Fundus photo; 2048x1536px: 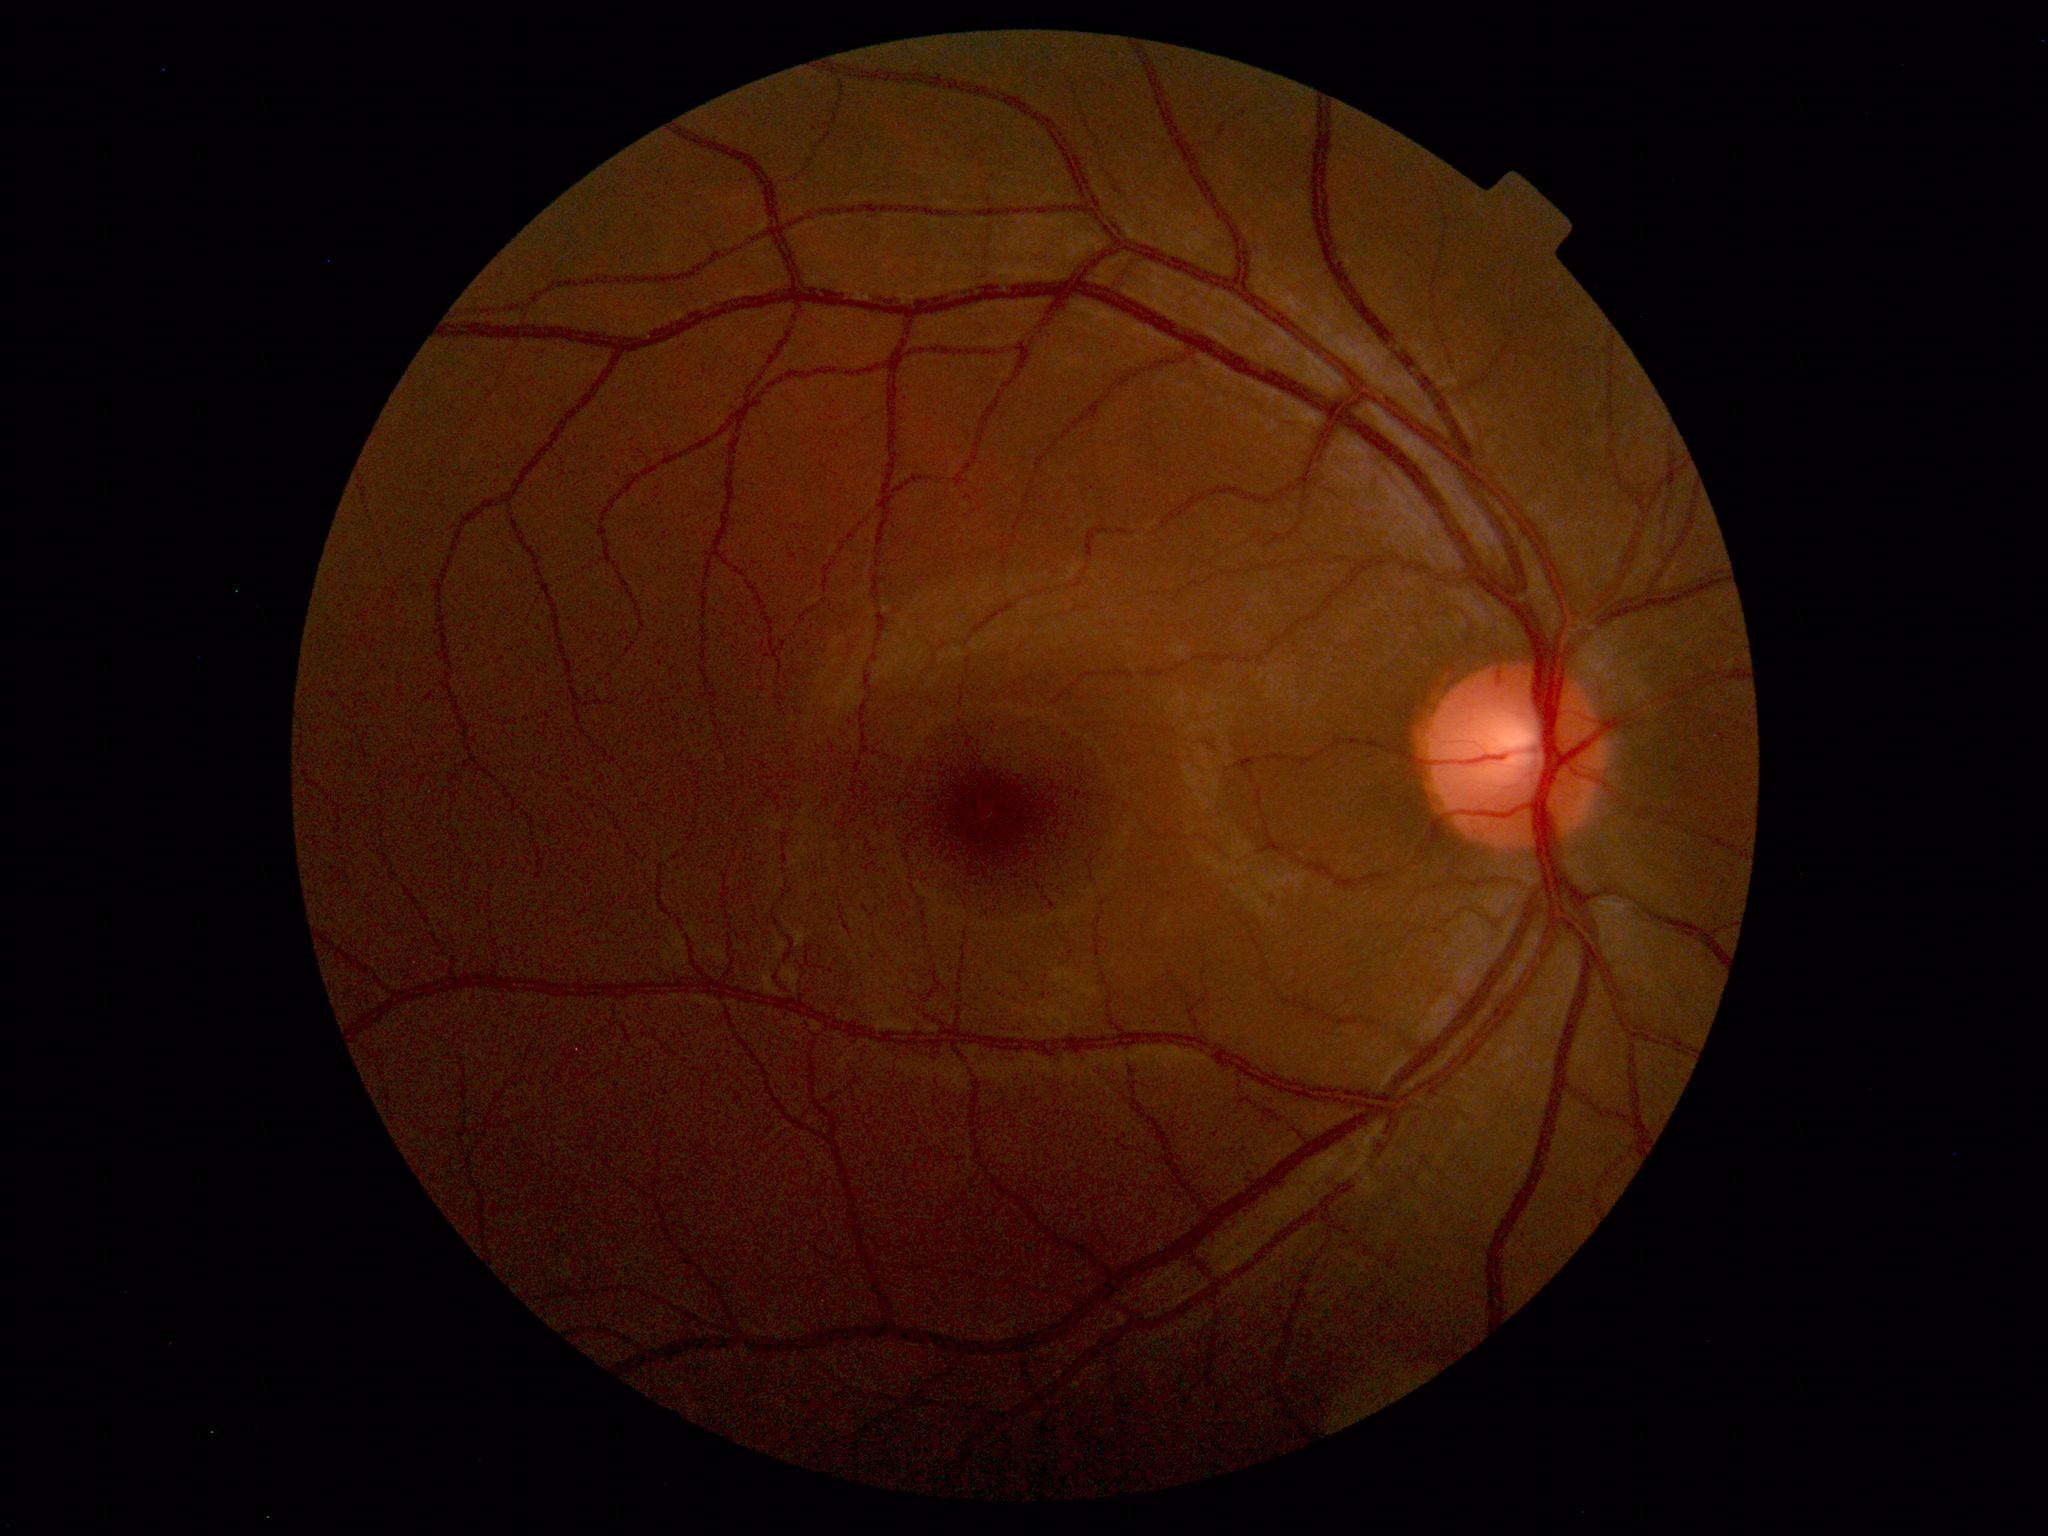
Findings: none. Normal fundus.